Tabletop color fundus camera image; 45-degree field of view:
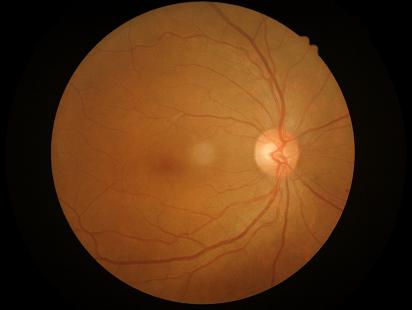 Illumination: good illumination and color balance; Contrast: vessels and details readily distinguishable; Overall image quality: good, gradable.